Captured on a Remidio Fundus on Phone (FOP) camera.
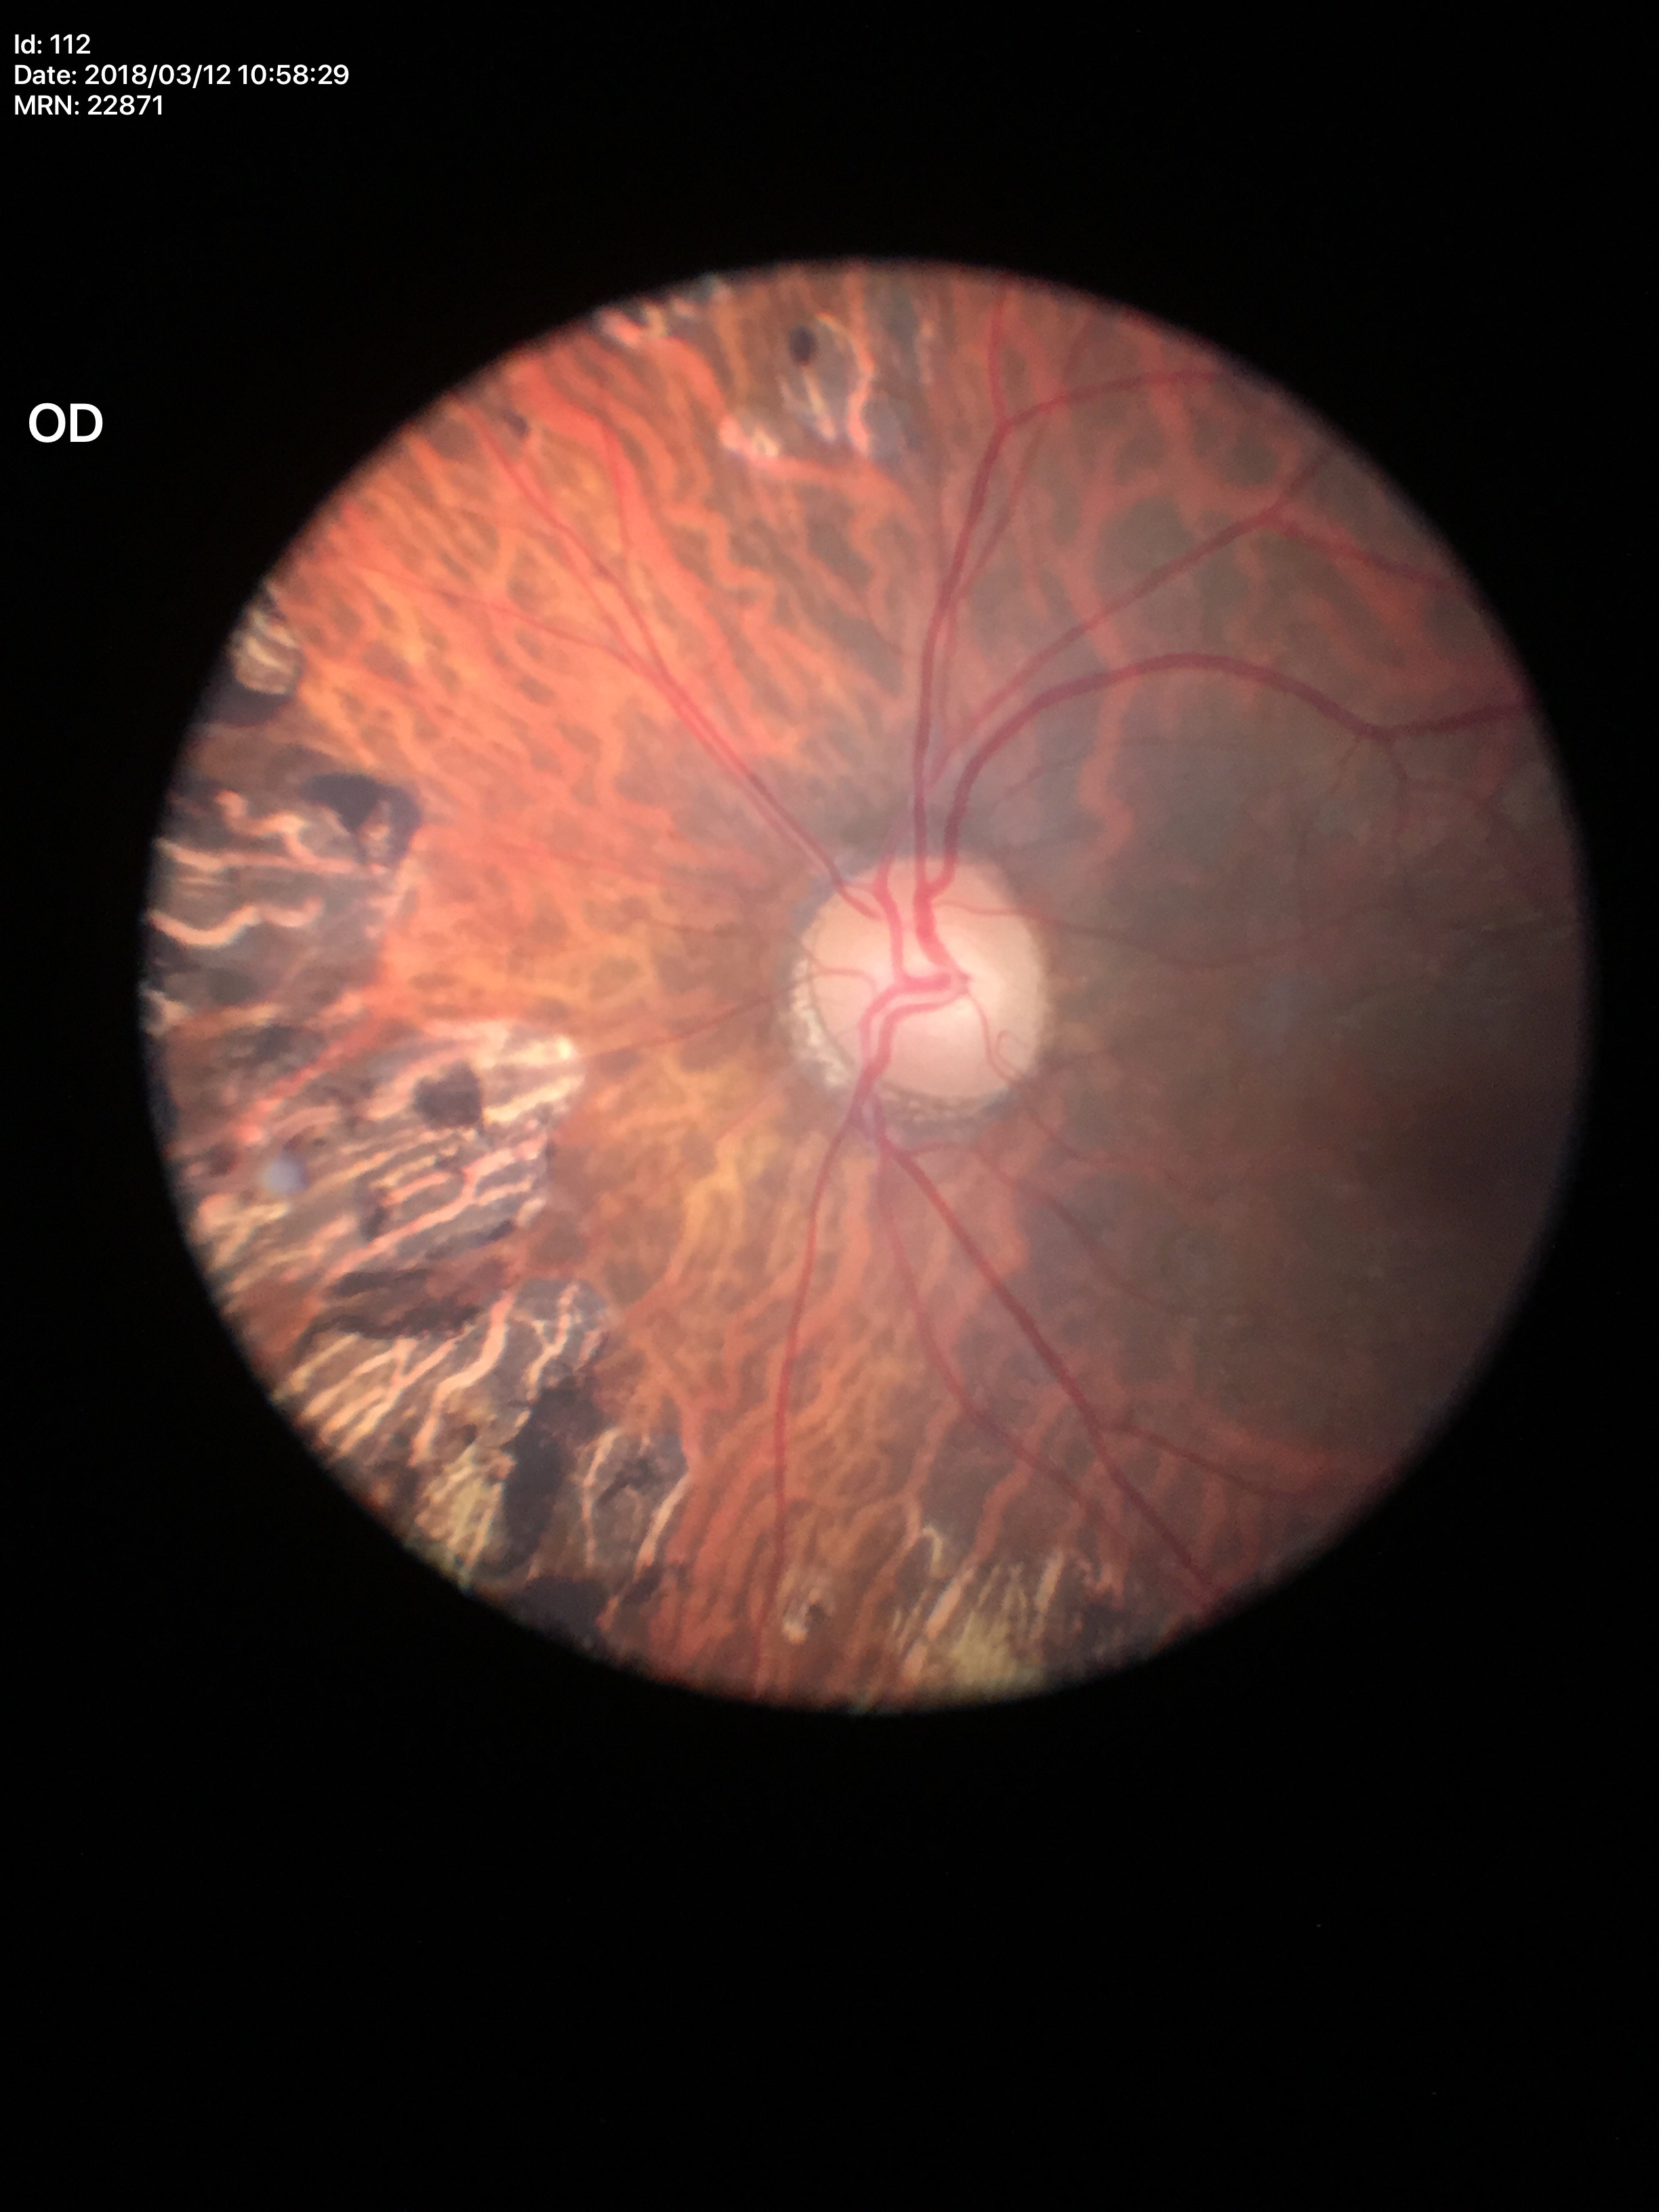
VCDR: 0.49. HCDR of 0.51. Glaucoma decision: negative.